2352x1568px. Fundus photo. FOV: 45 degrees — 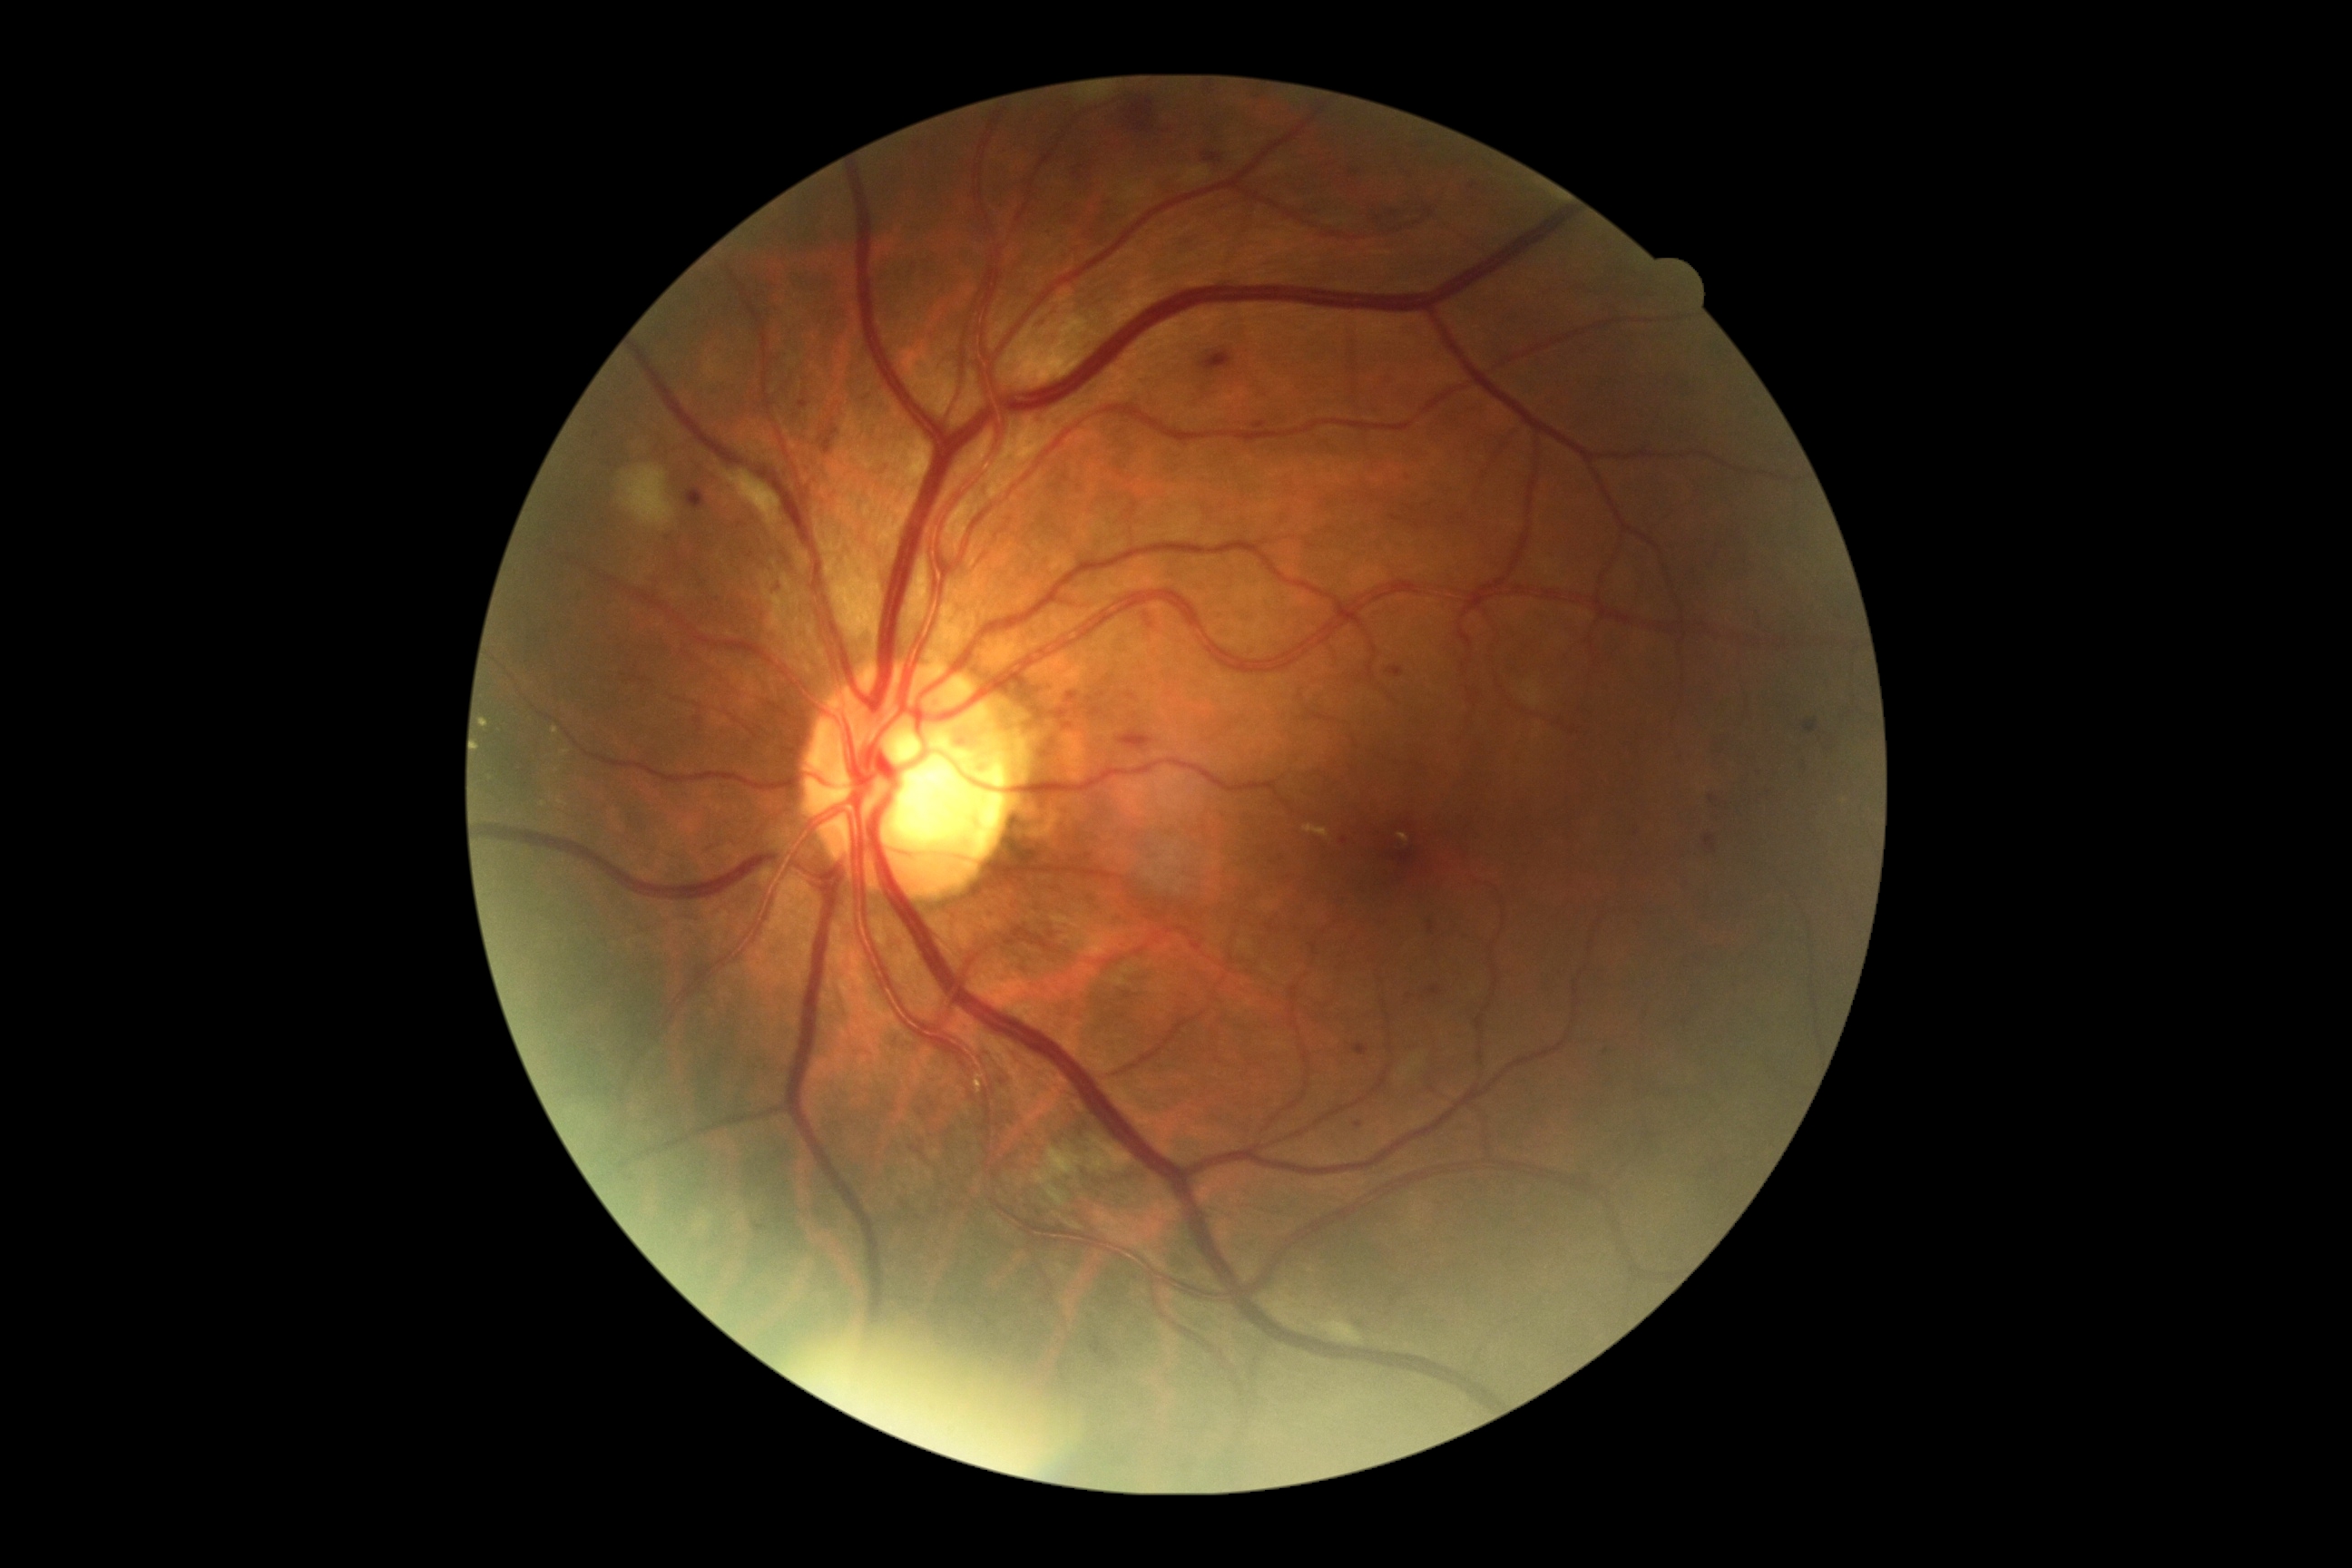 * DR class: non-proliferative diabetic retinopathy
* retinopathy: moderate NPDR (grade 2) — more than just microaneurysms but less than severe NPDR